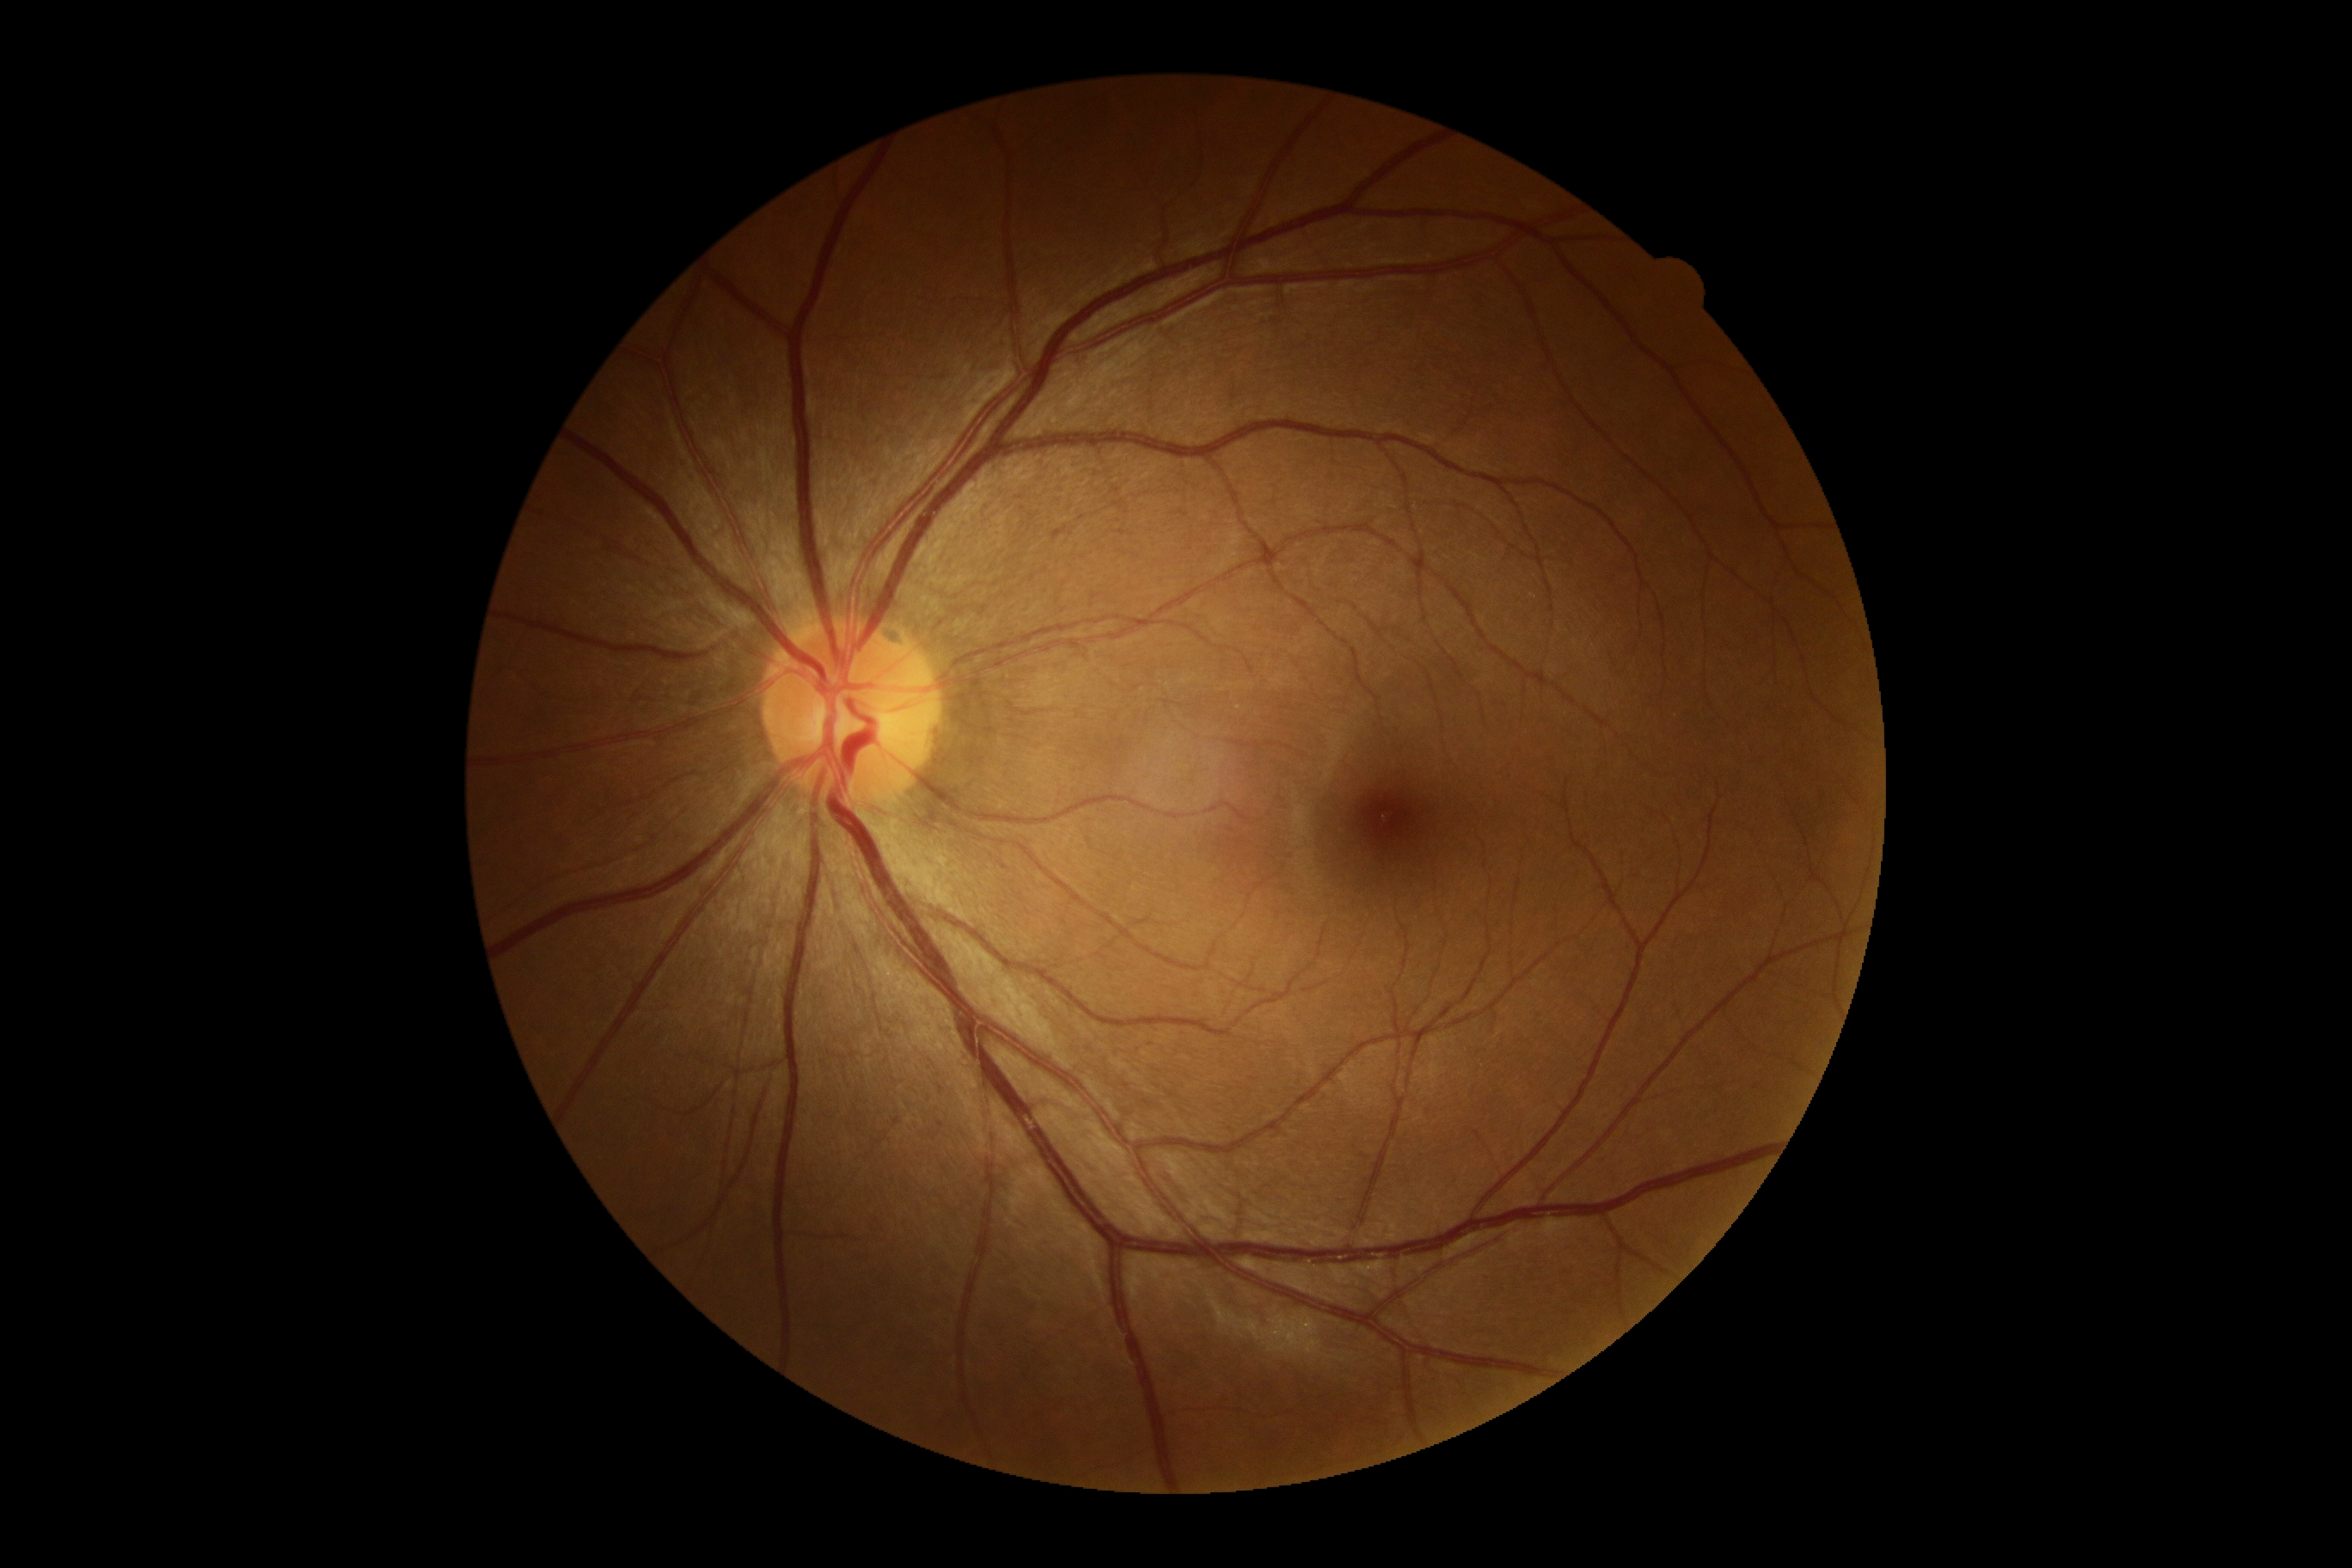

No DR findings. Diabetic retinopathy grade is 0 (no apparent retinopathy) — no visible signs of diabetic retinopathy.